DR severity per modified Davis staging; nonmydriatic fundus photograph; NIDEK AFC-230; 45° field of view — 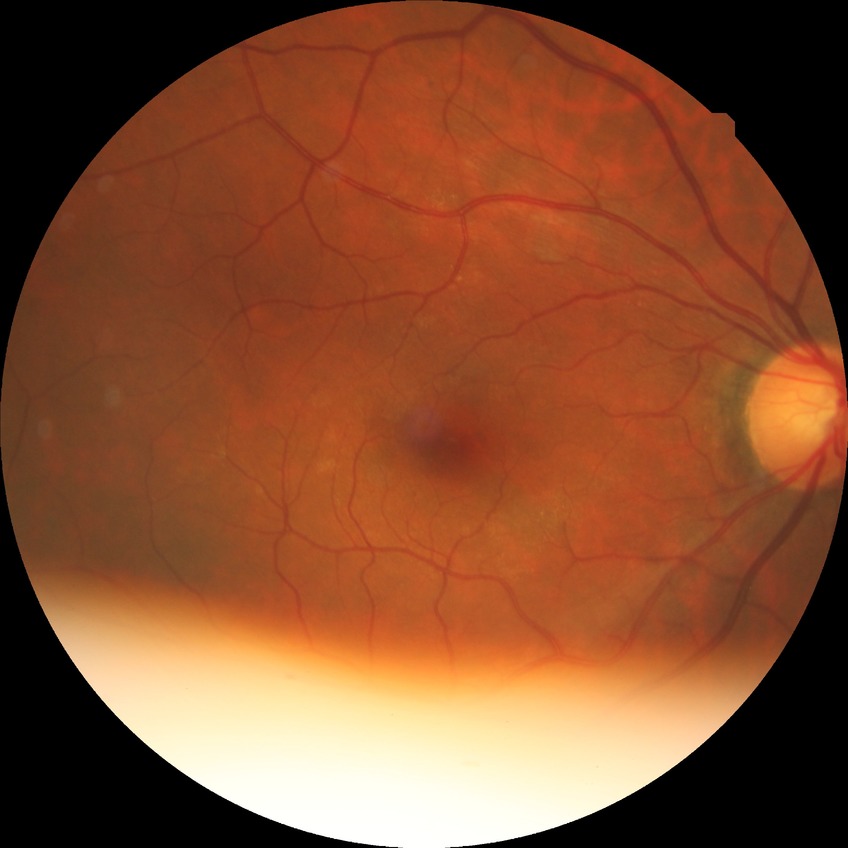 Davis grading = no diabetic retinopathy.